Retinal fundus photograph: 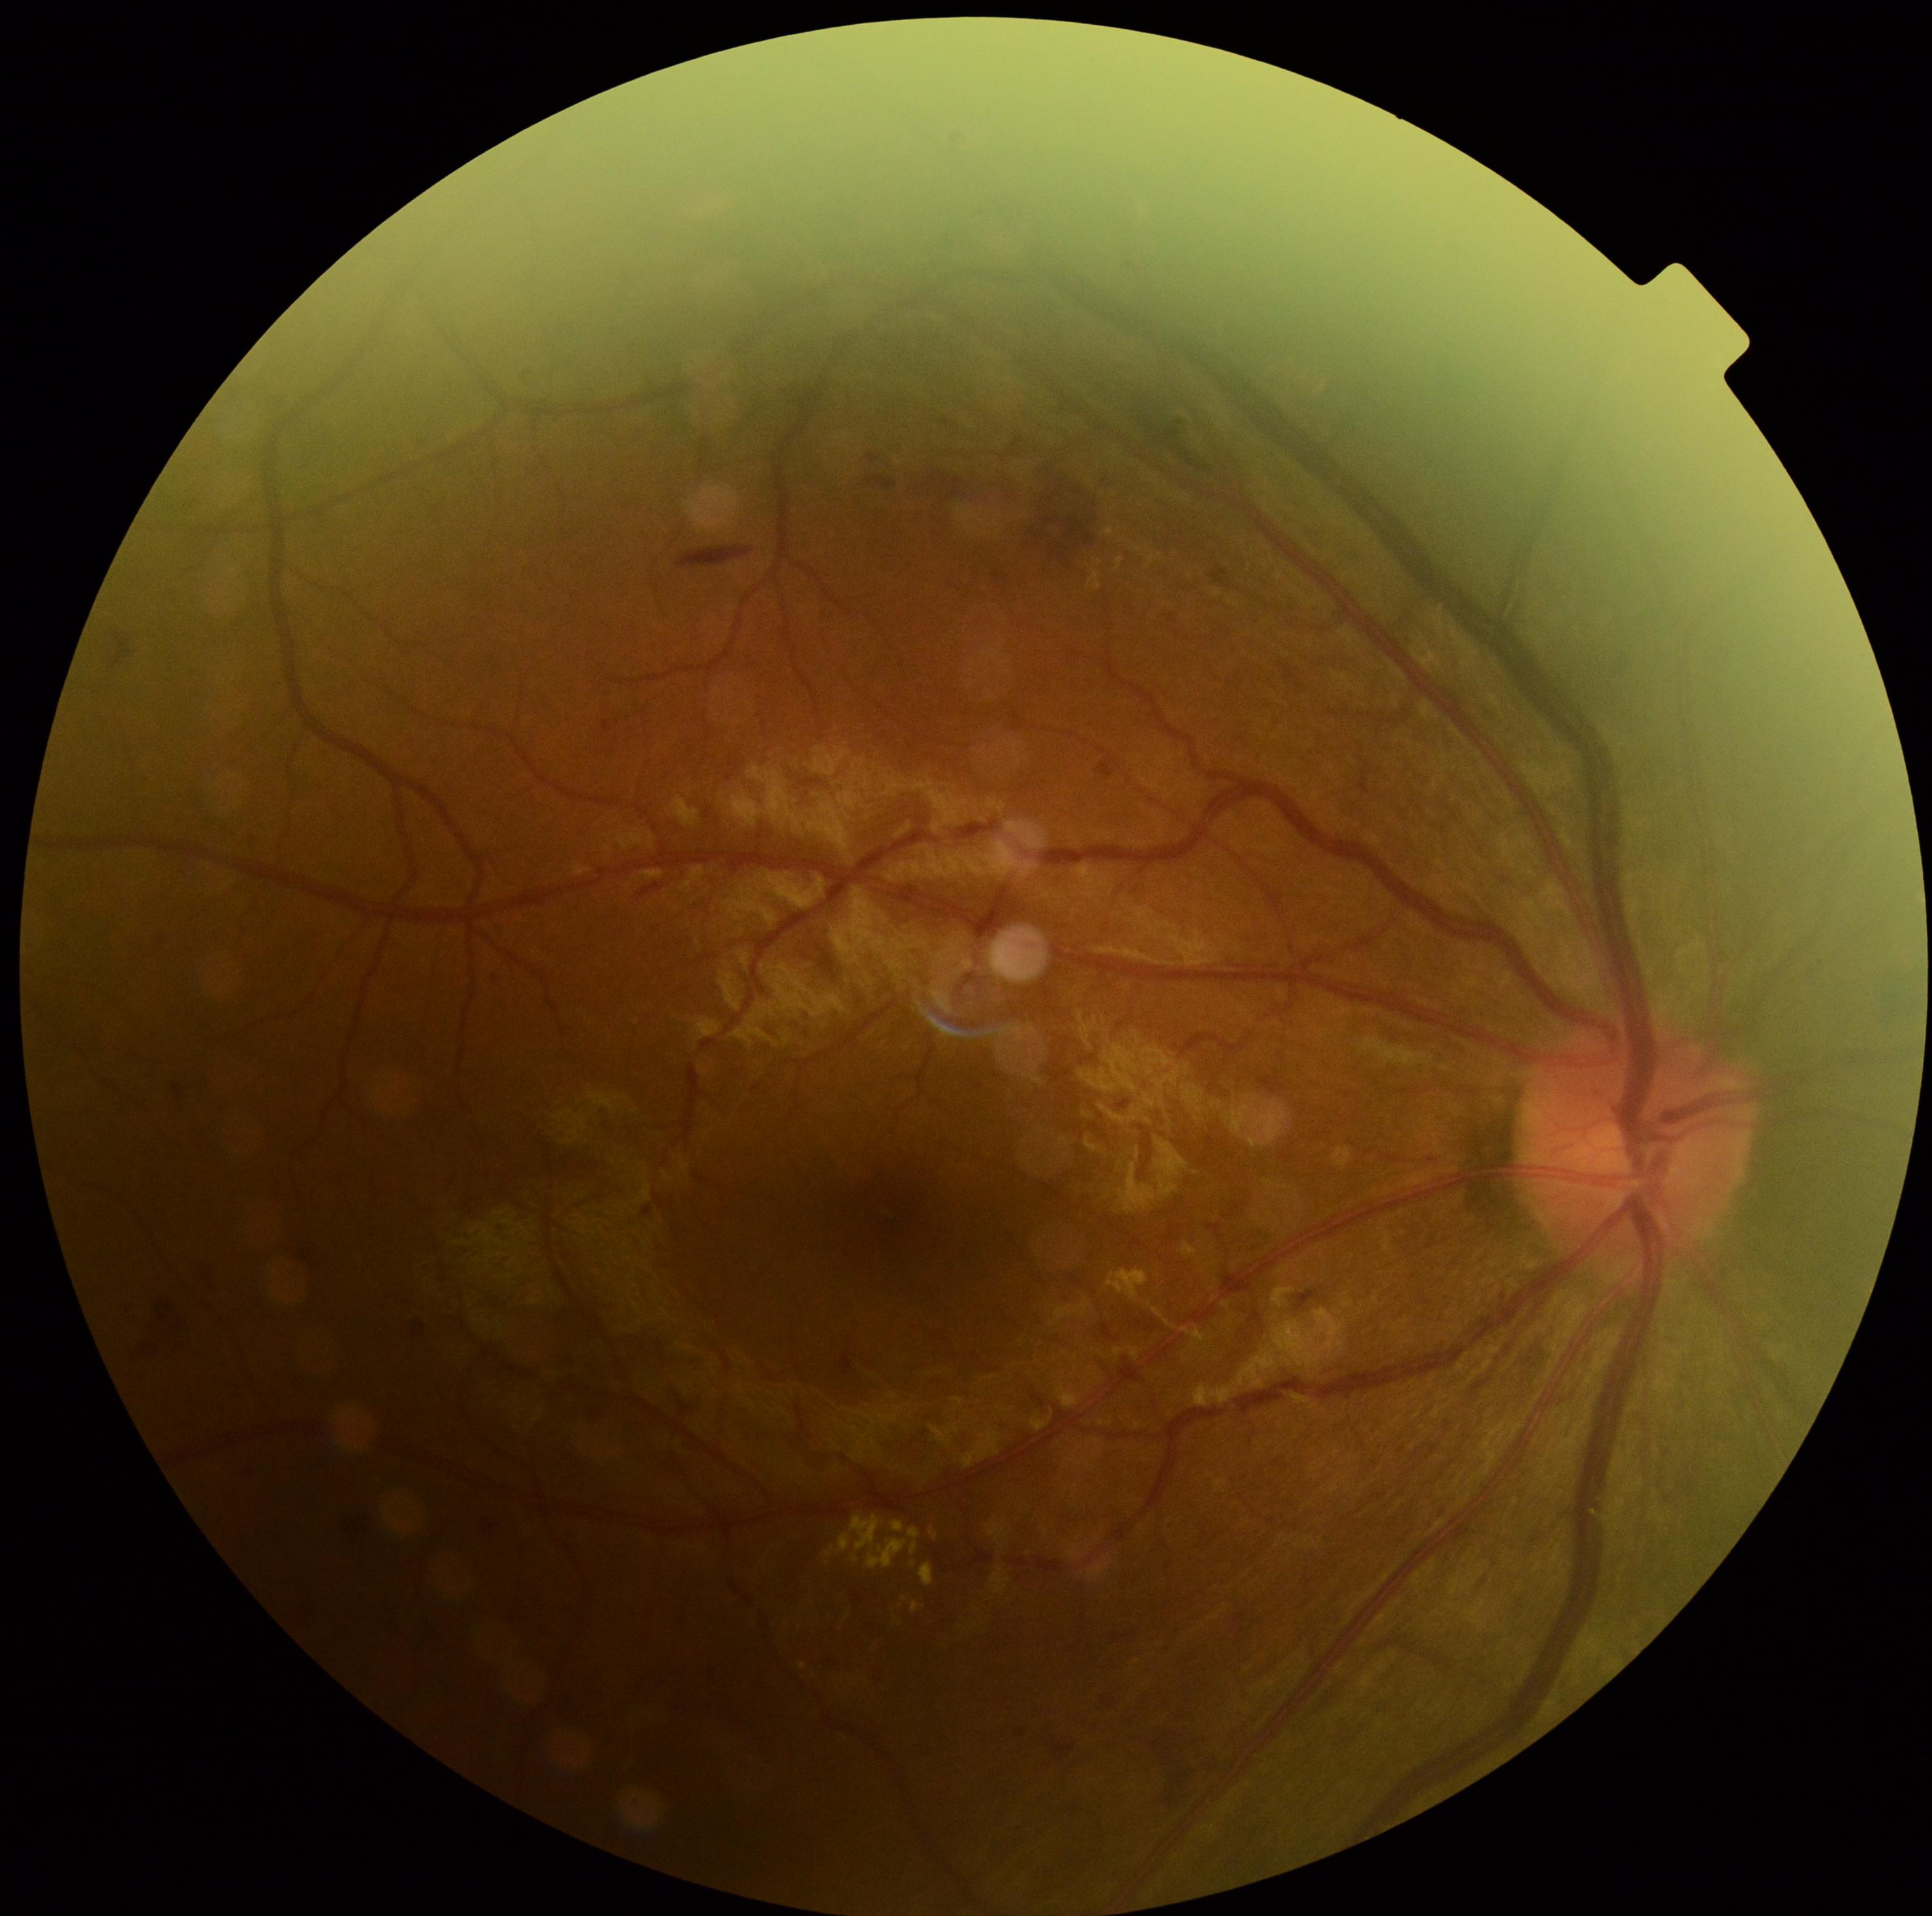
DR class: non-proliferative diabetic retinopathy, diabetic retinopathy (DR): 2/4.